Ultra-widefield fundus photograph
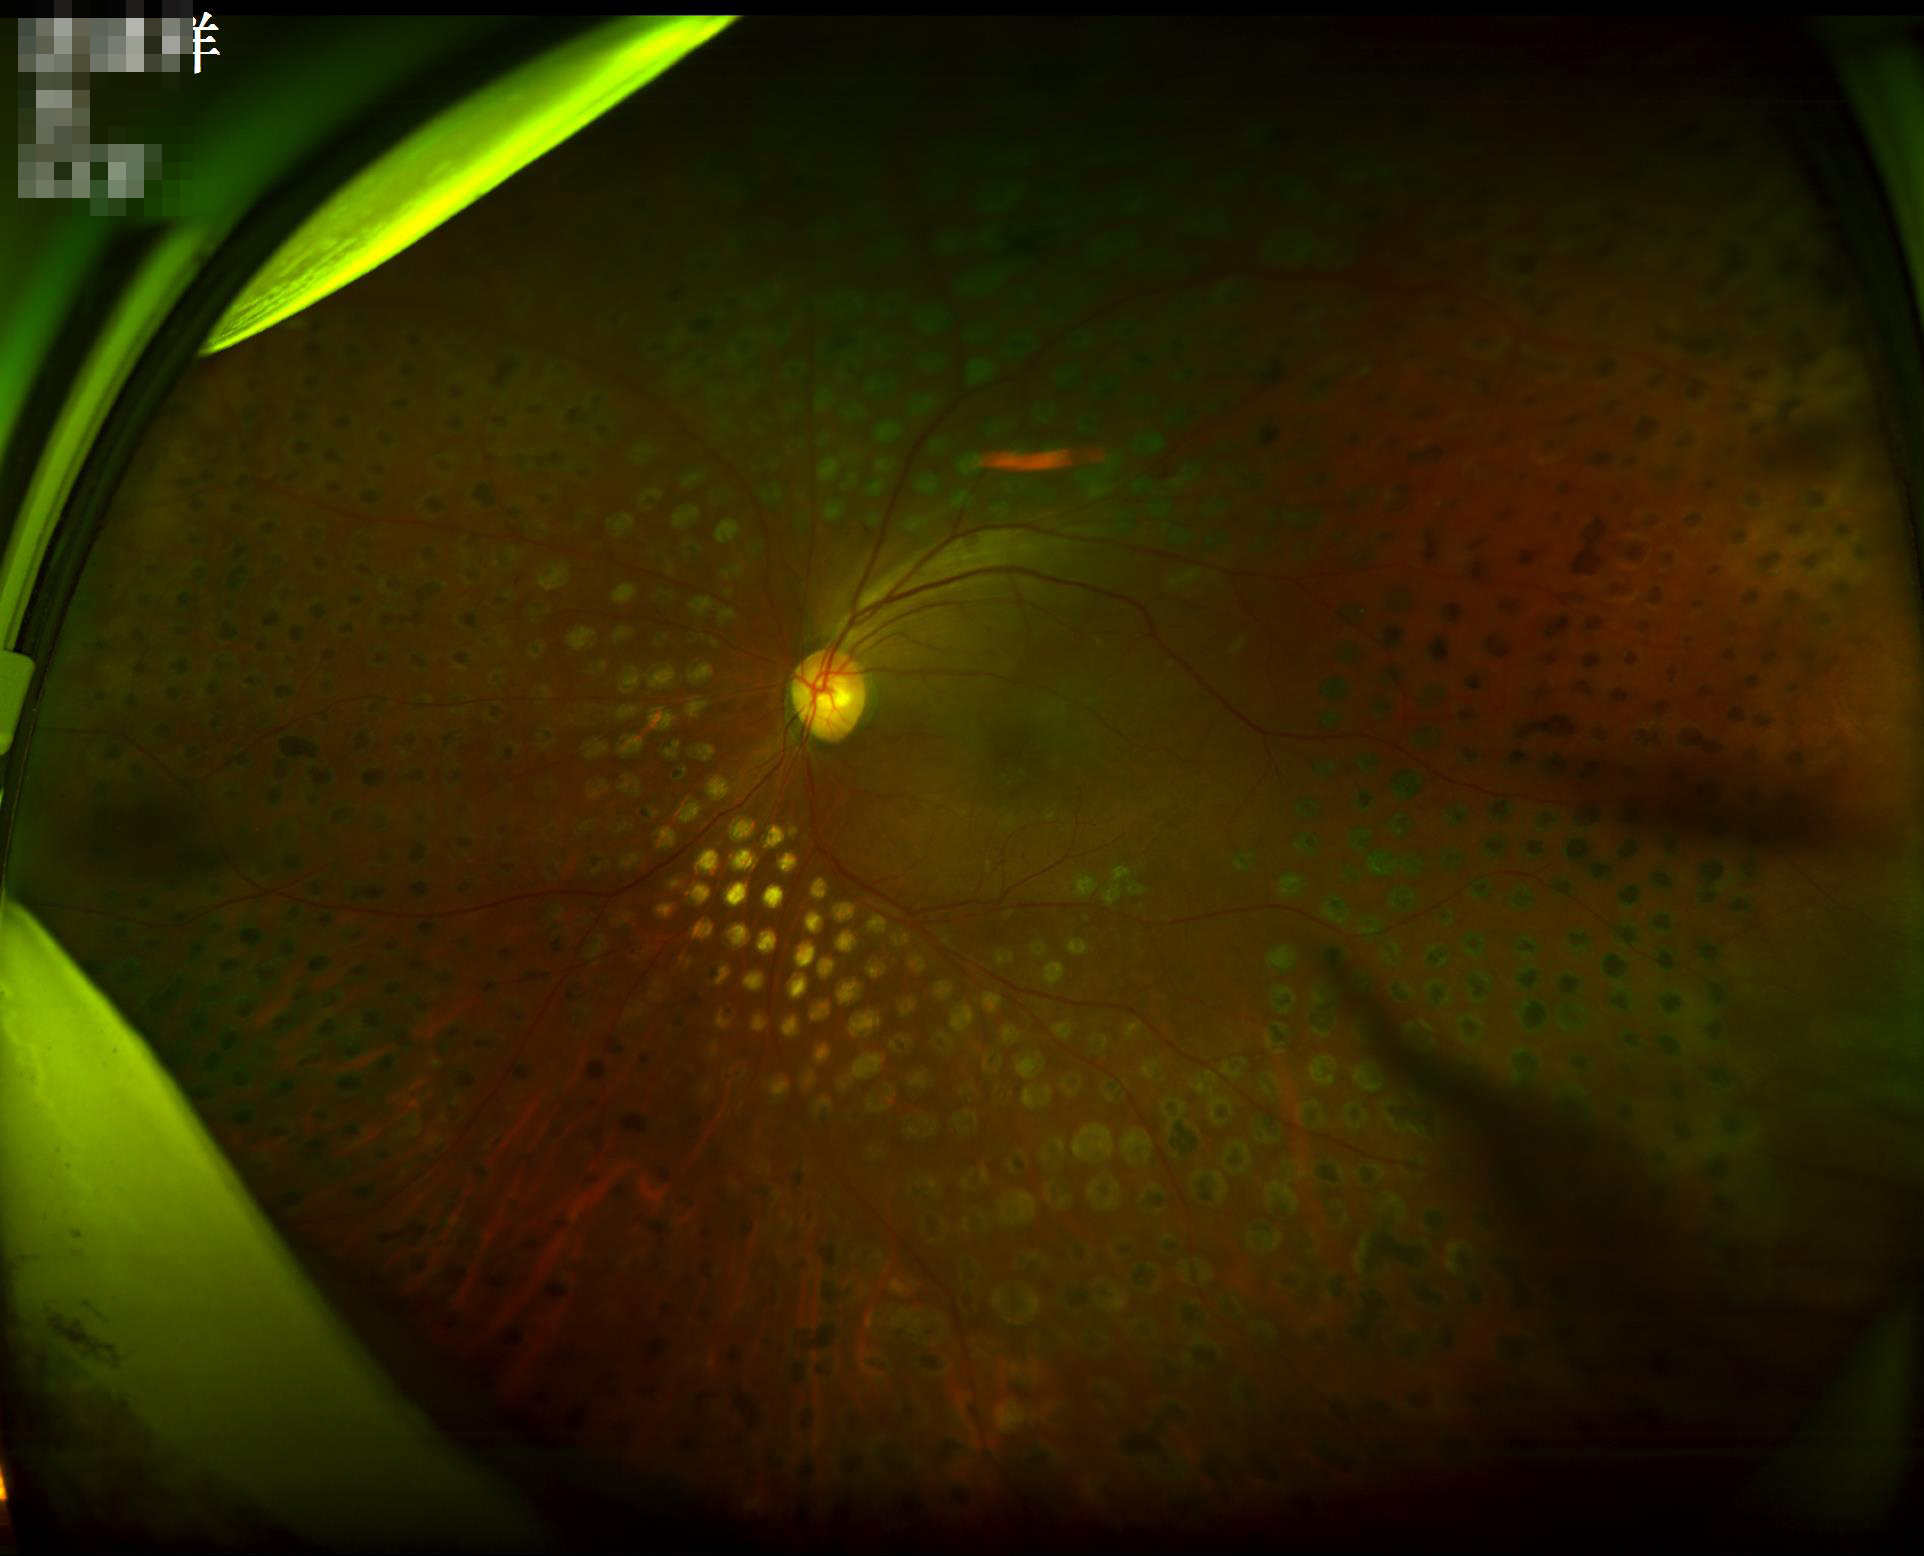

Acceptable image quality. Illumination is uneven. Vessels and details are readily distinguishable.